IOP: 16 mmHg · male · centered on the optic disc · age 61: 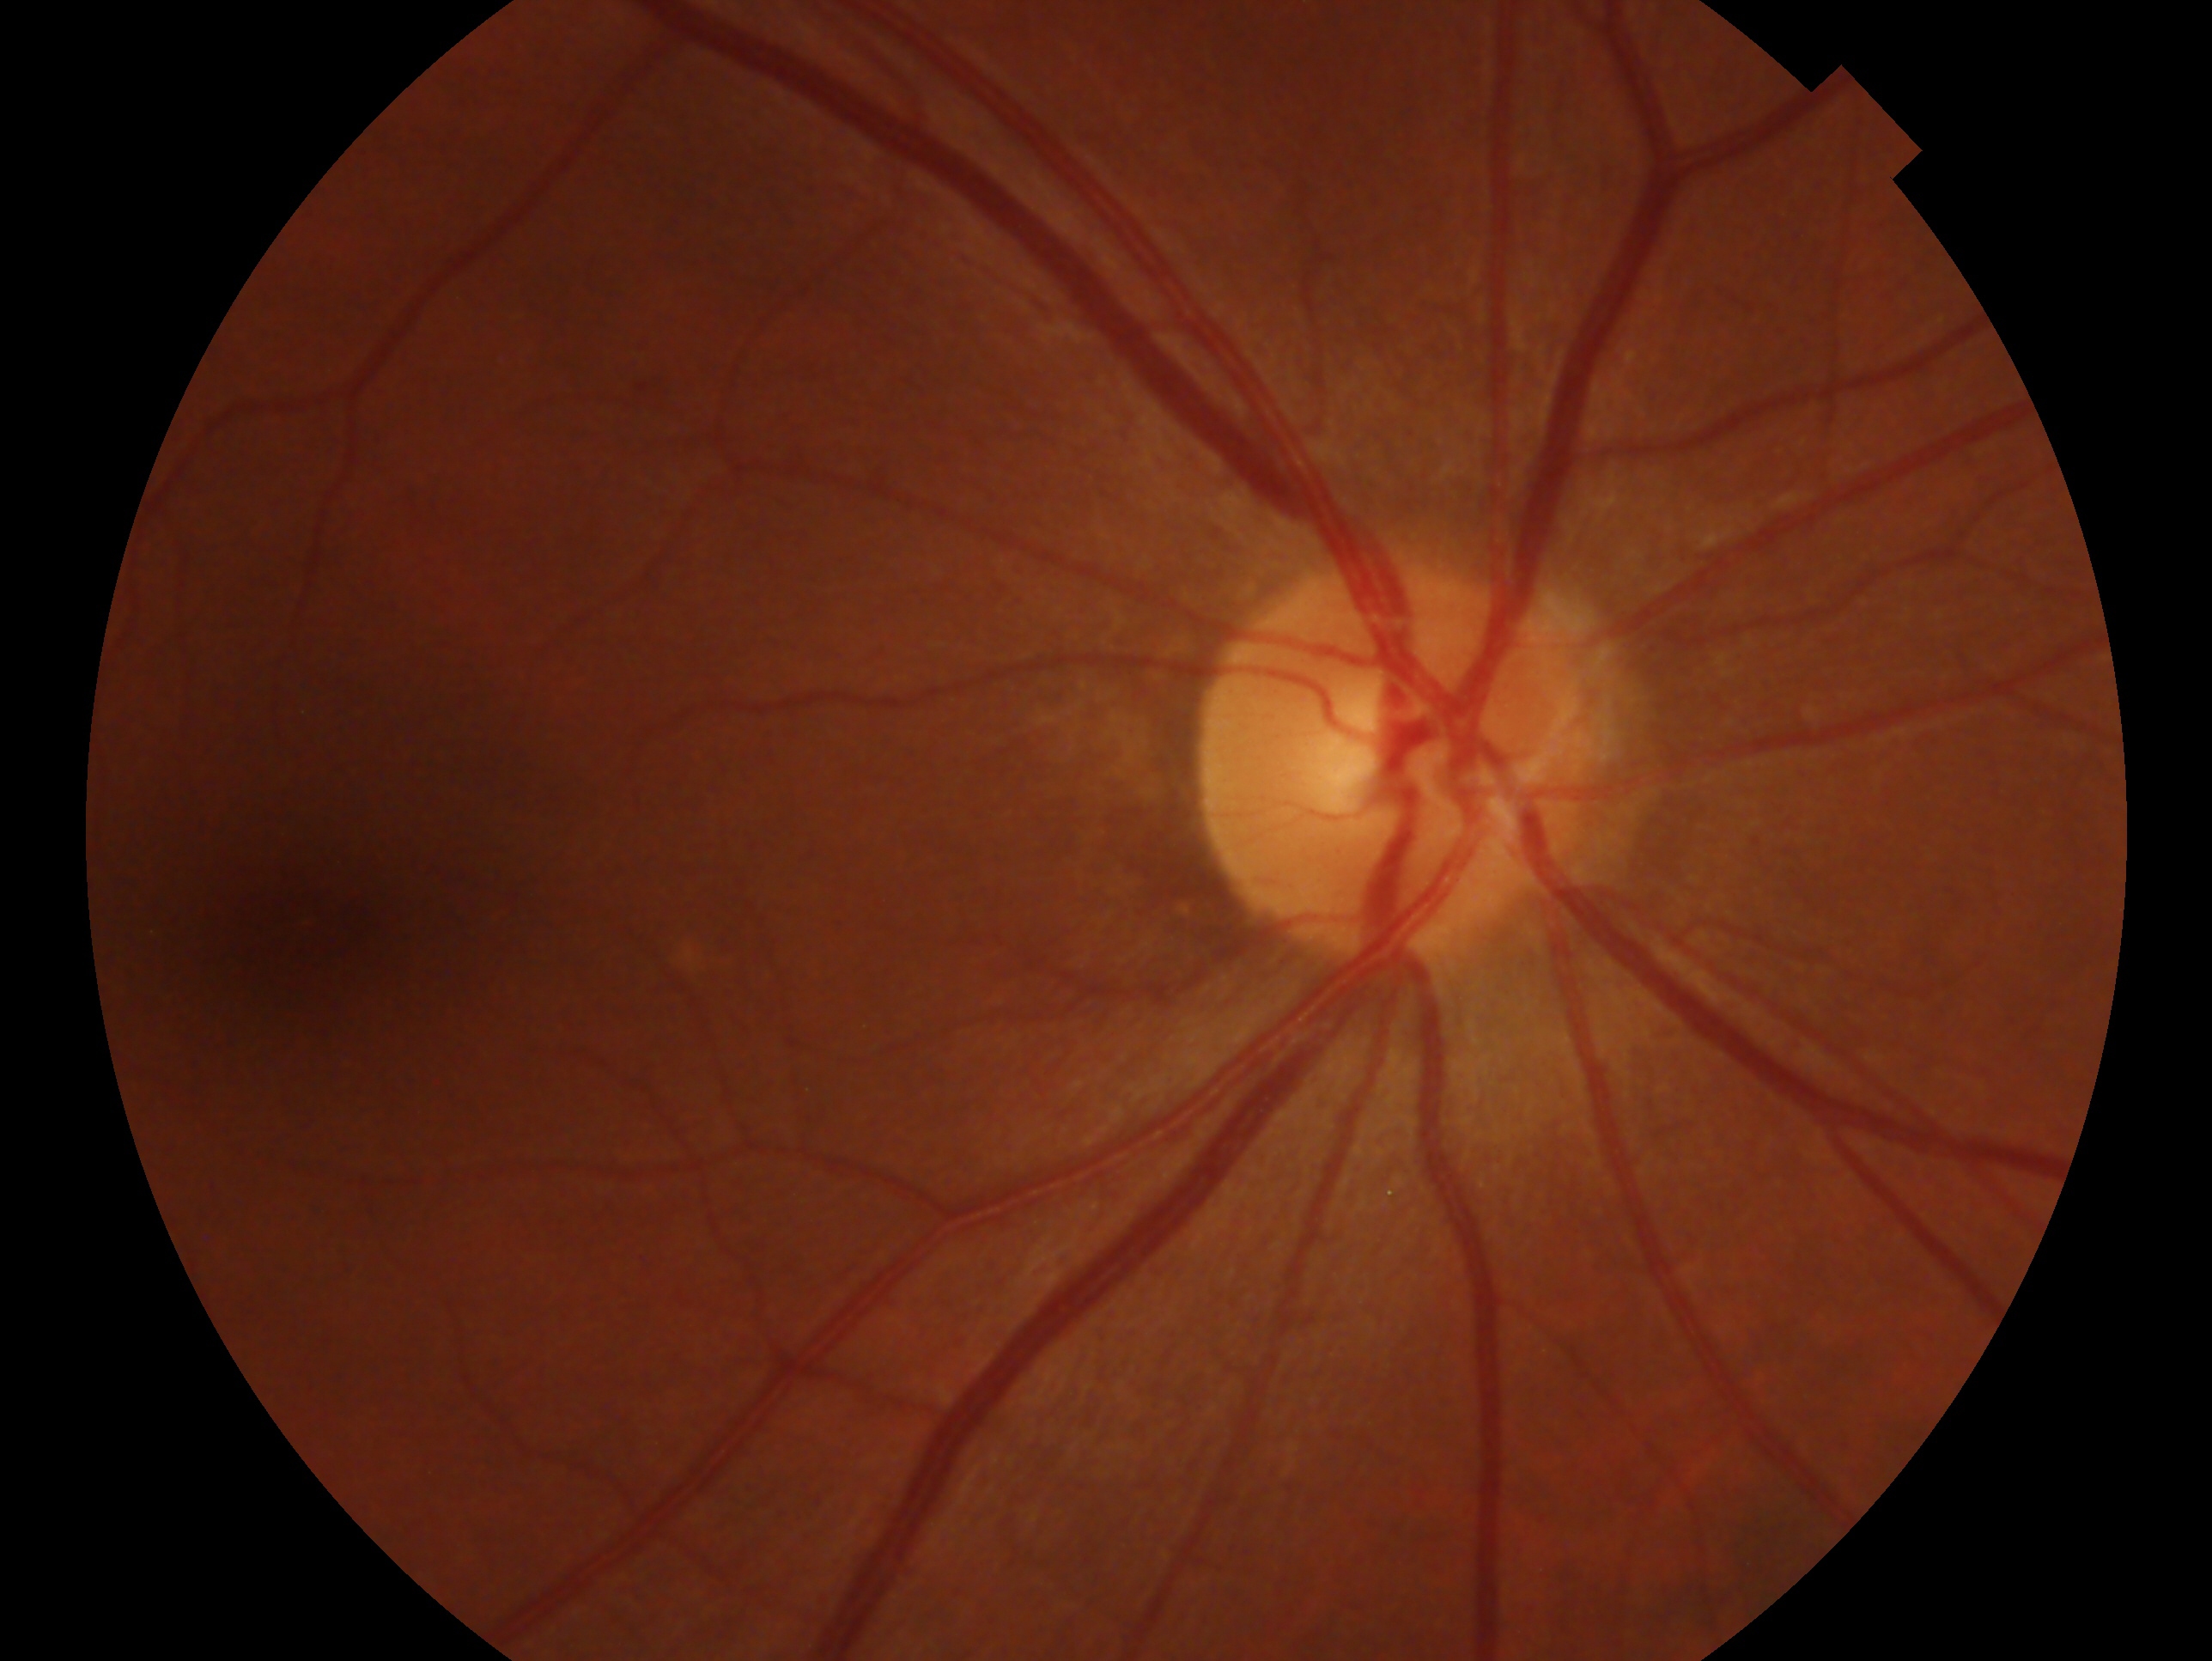

Imaged eye: right. Diagnosis — no glaucomatous findings.